Modified Davis classification: 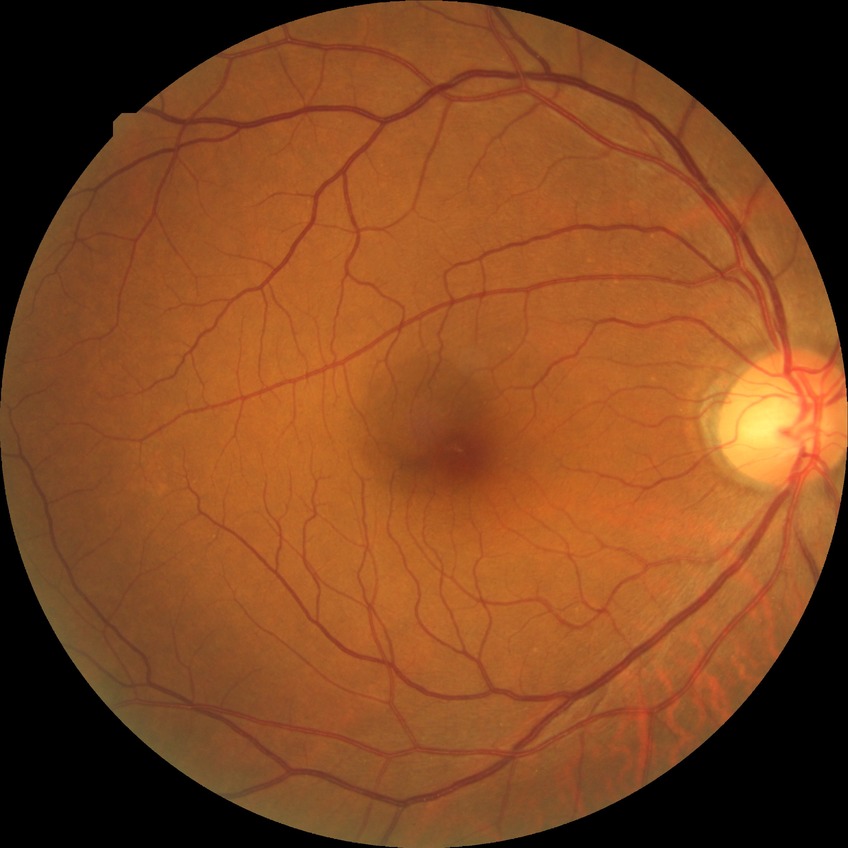
{
  "davis_grade": "no diabetic retinopathy"
}